2352x1568px, color fundus image:
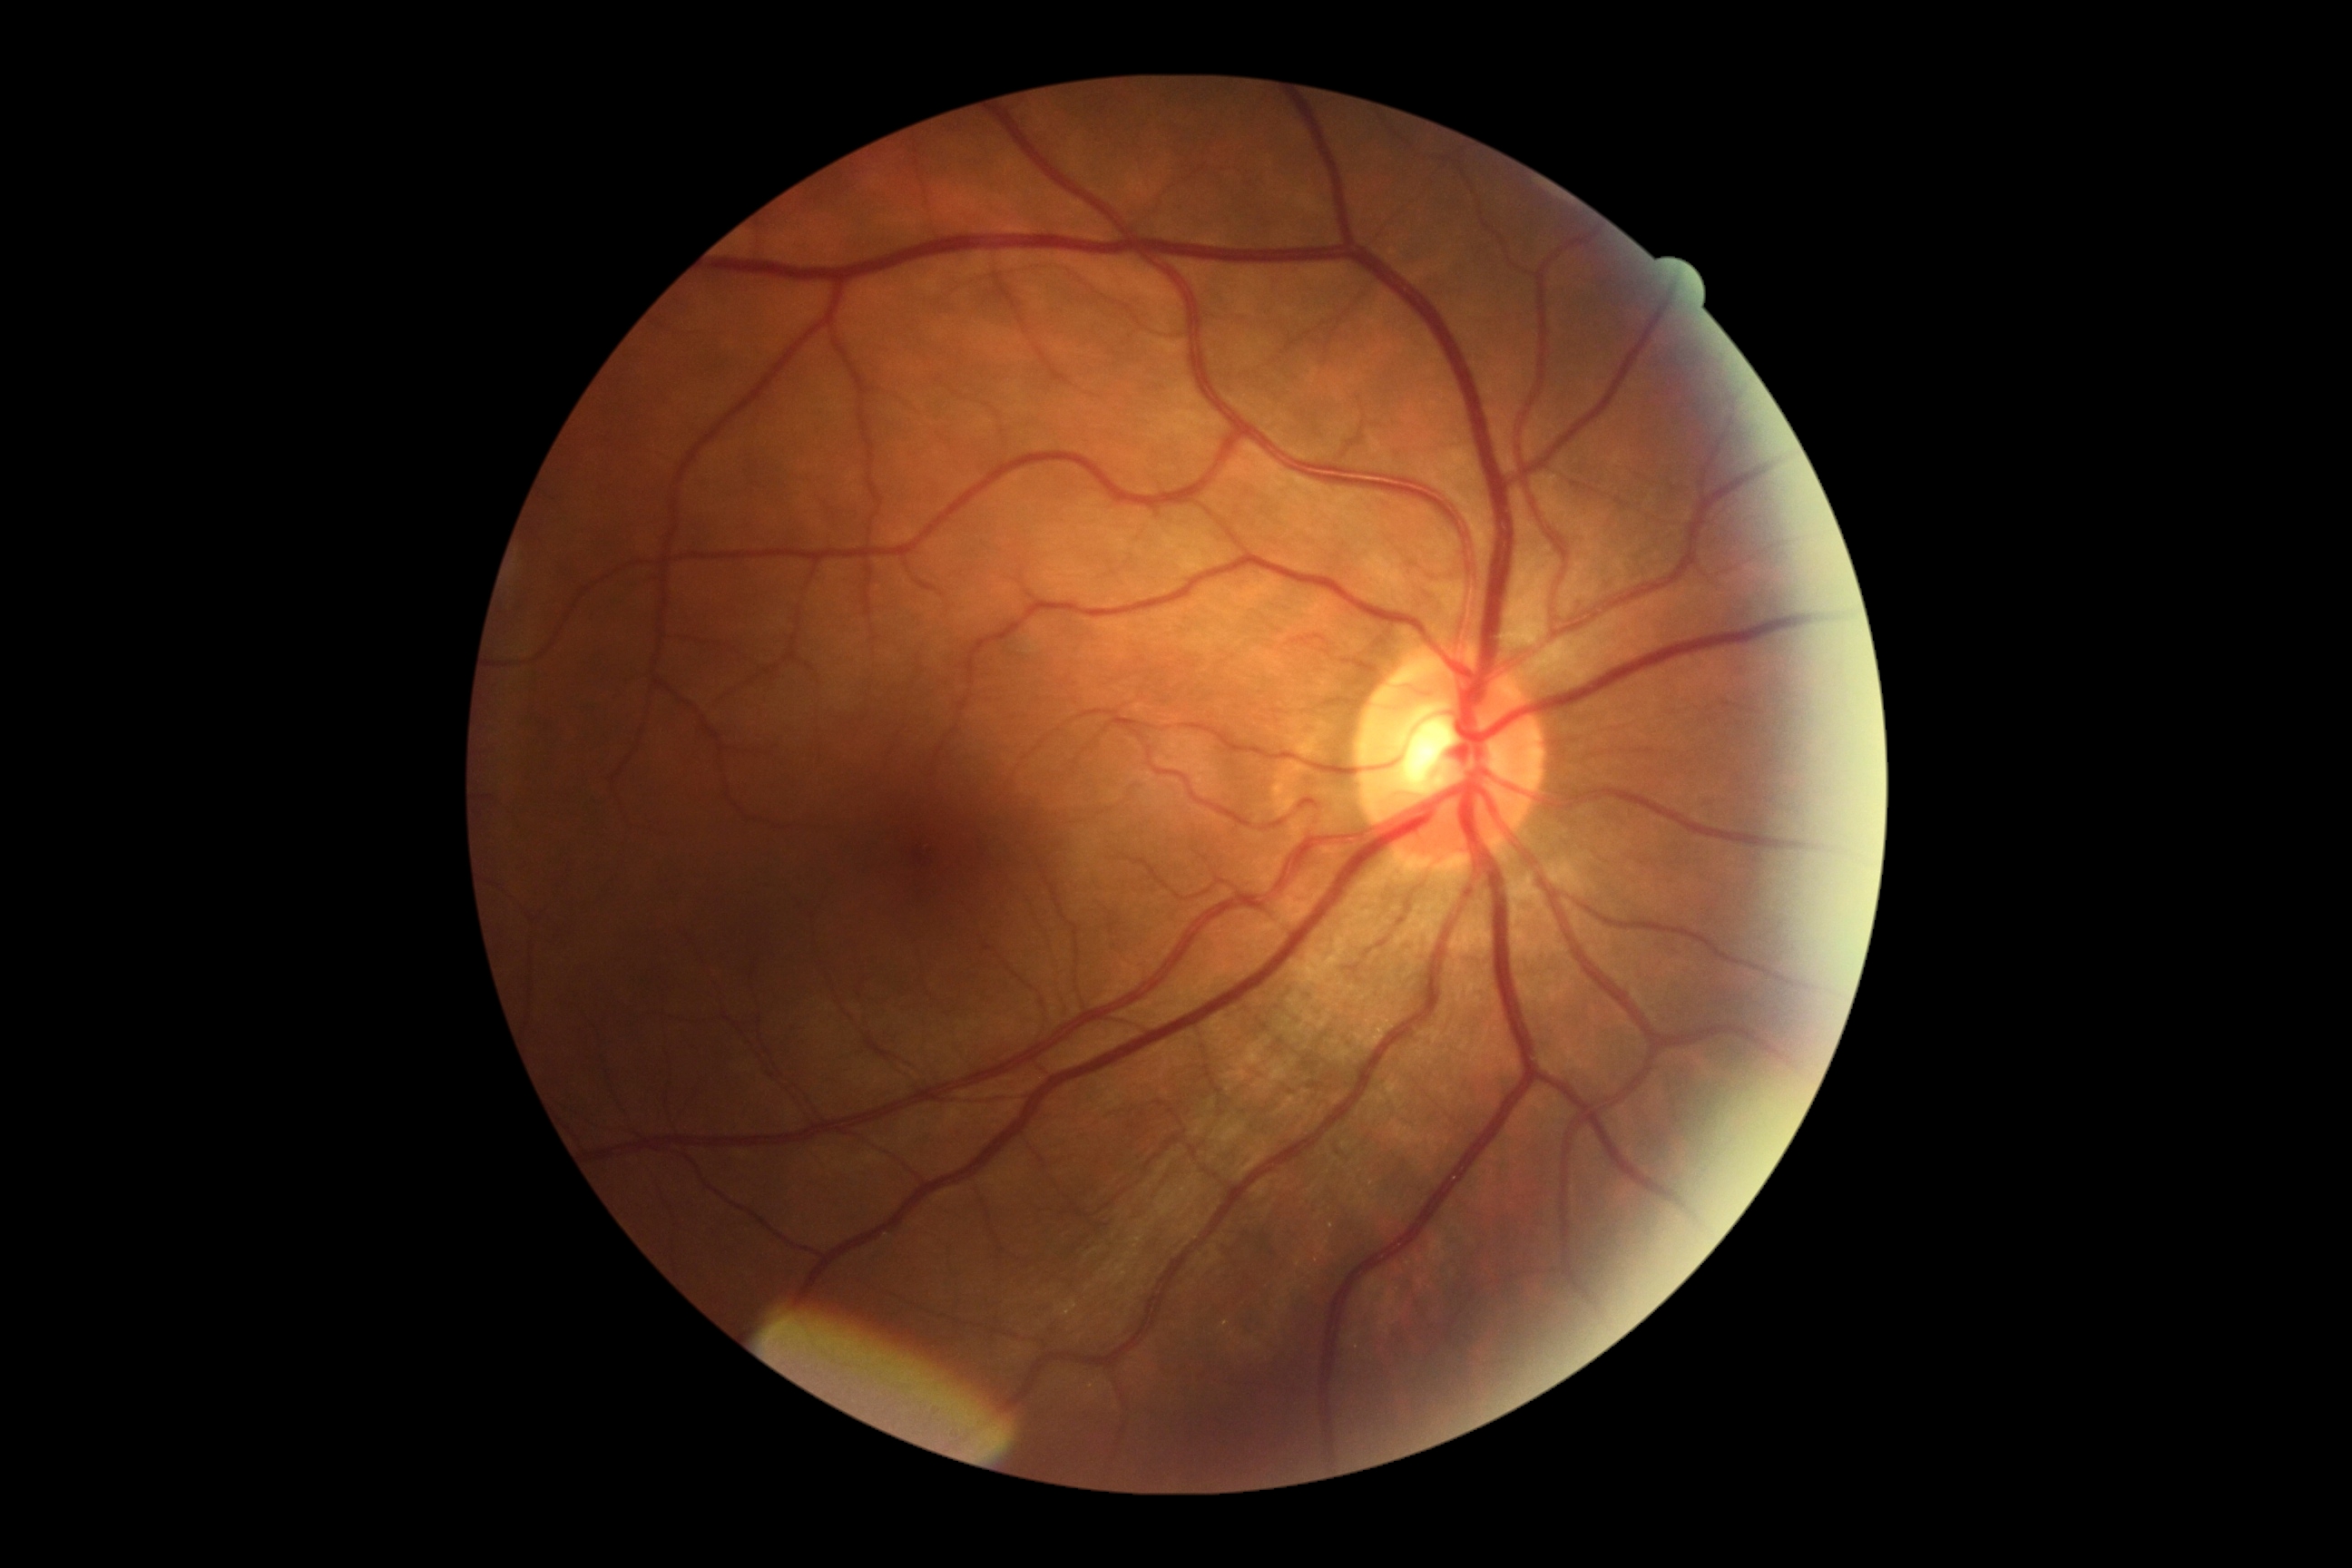 No diabetic retinal disease findings. DR is 0/4.